45-degree field of view. Davis DR grading.
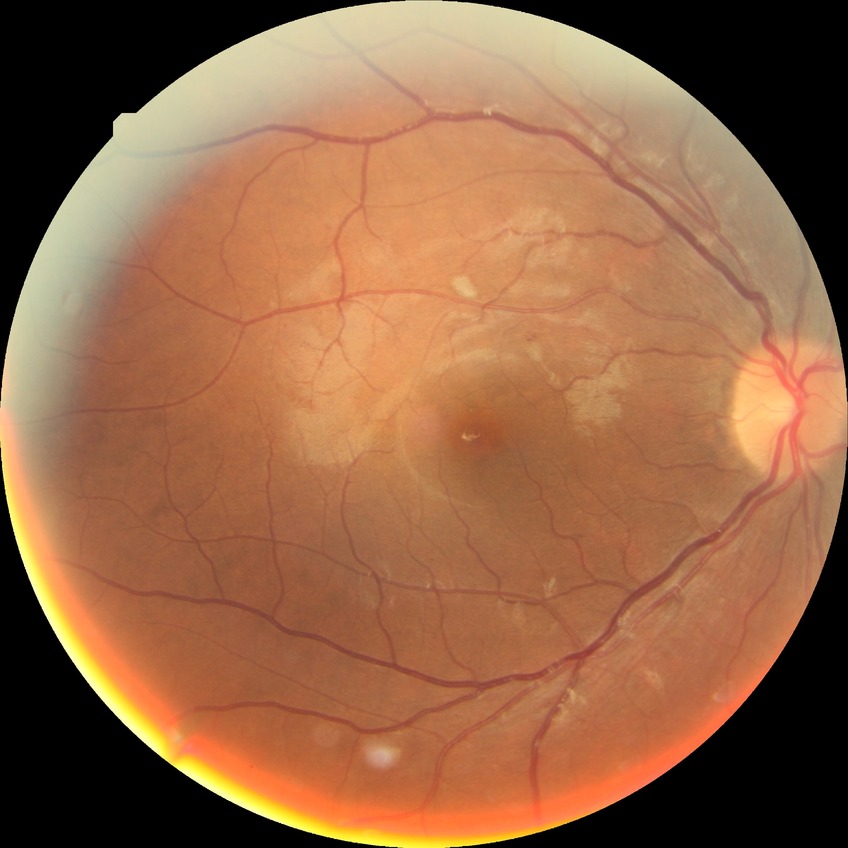

Modified Davis grading is no diabetic retinopathy.